848x848: 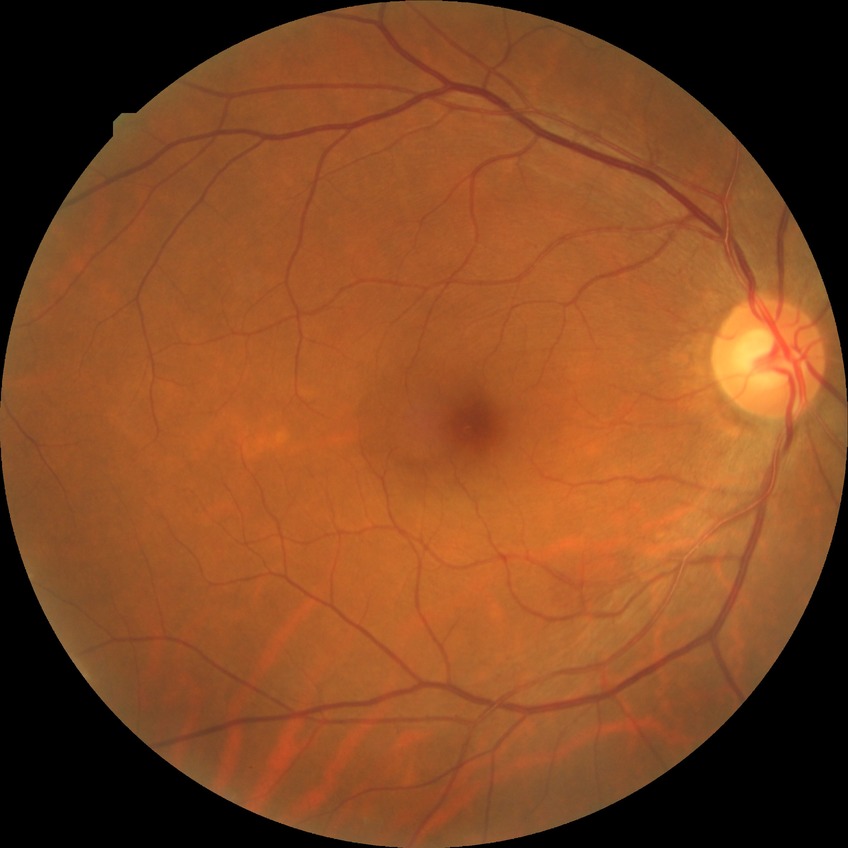 Findings:
* diabetic retinopathy (DR) — no diabetic retinopathy (NDR)